Image size 2212x1659.
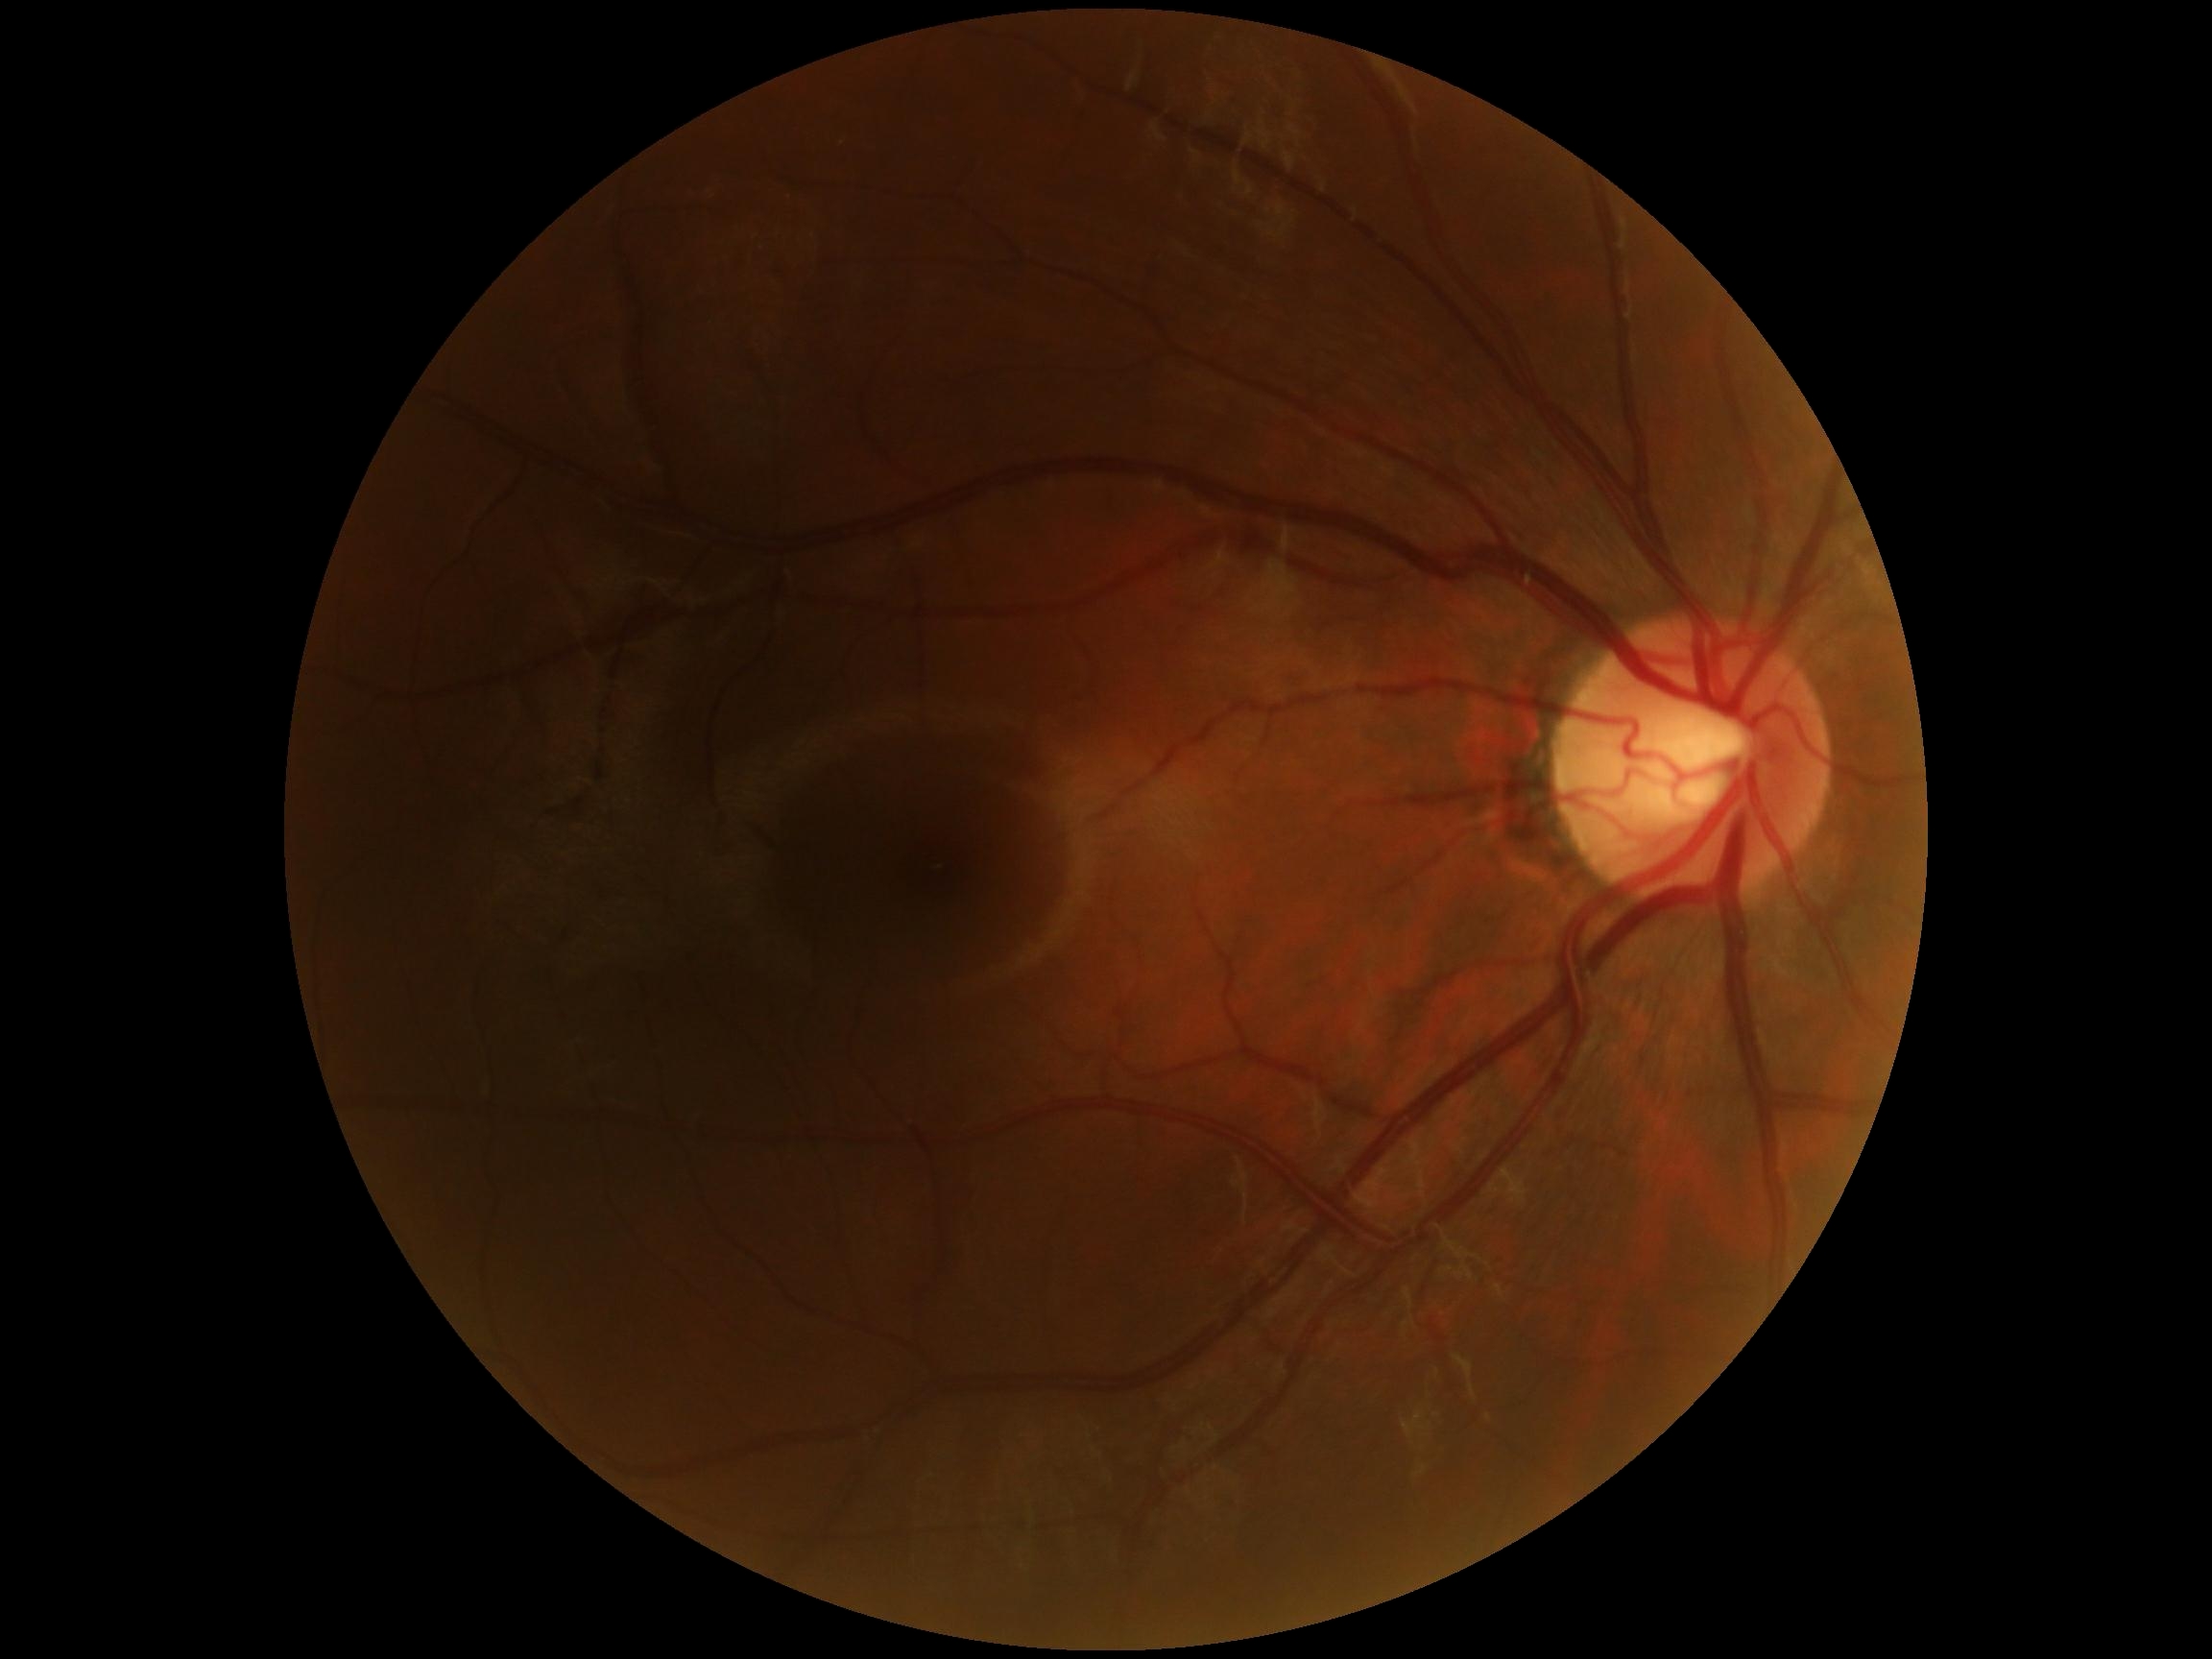
Retinopathy grade is 0 — no visible signs of diabetic retinopathy.
No DR findings.